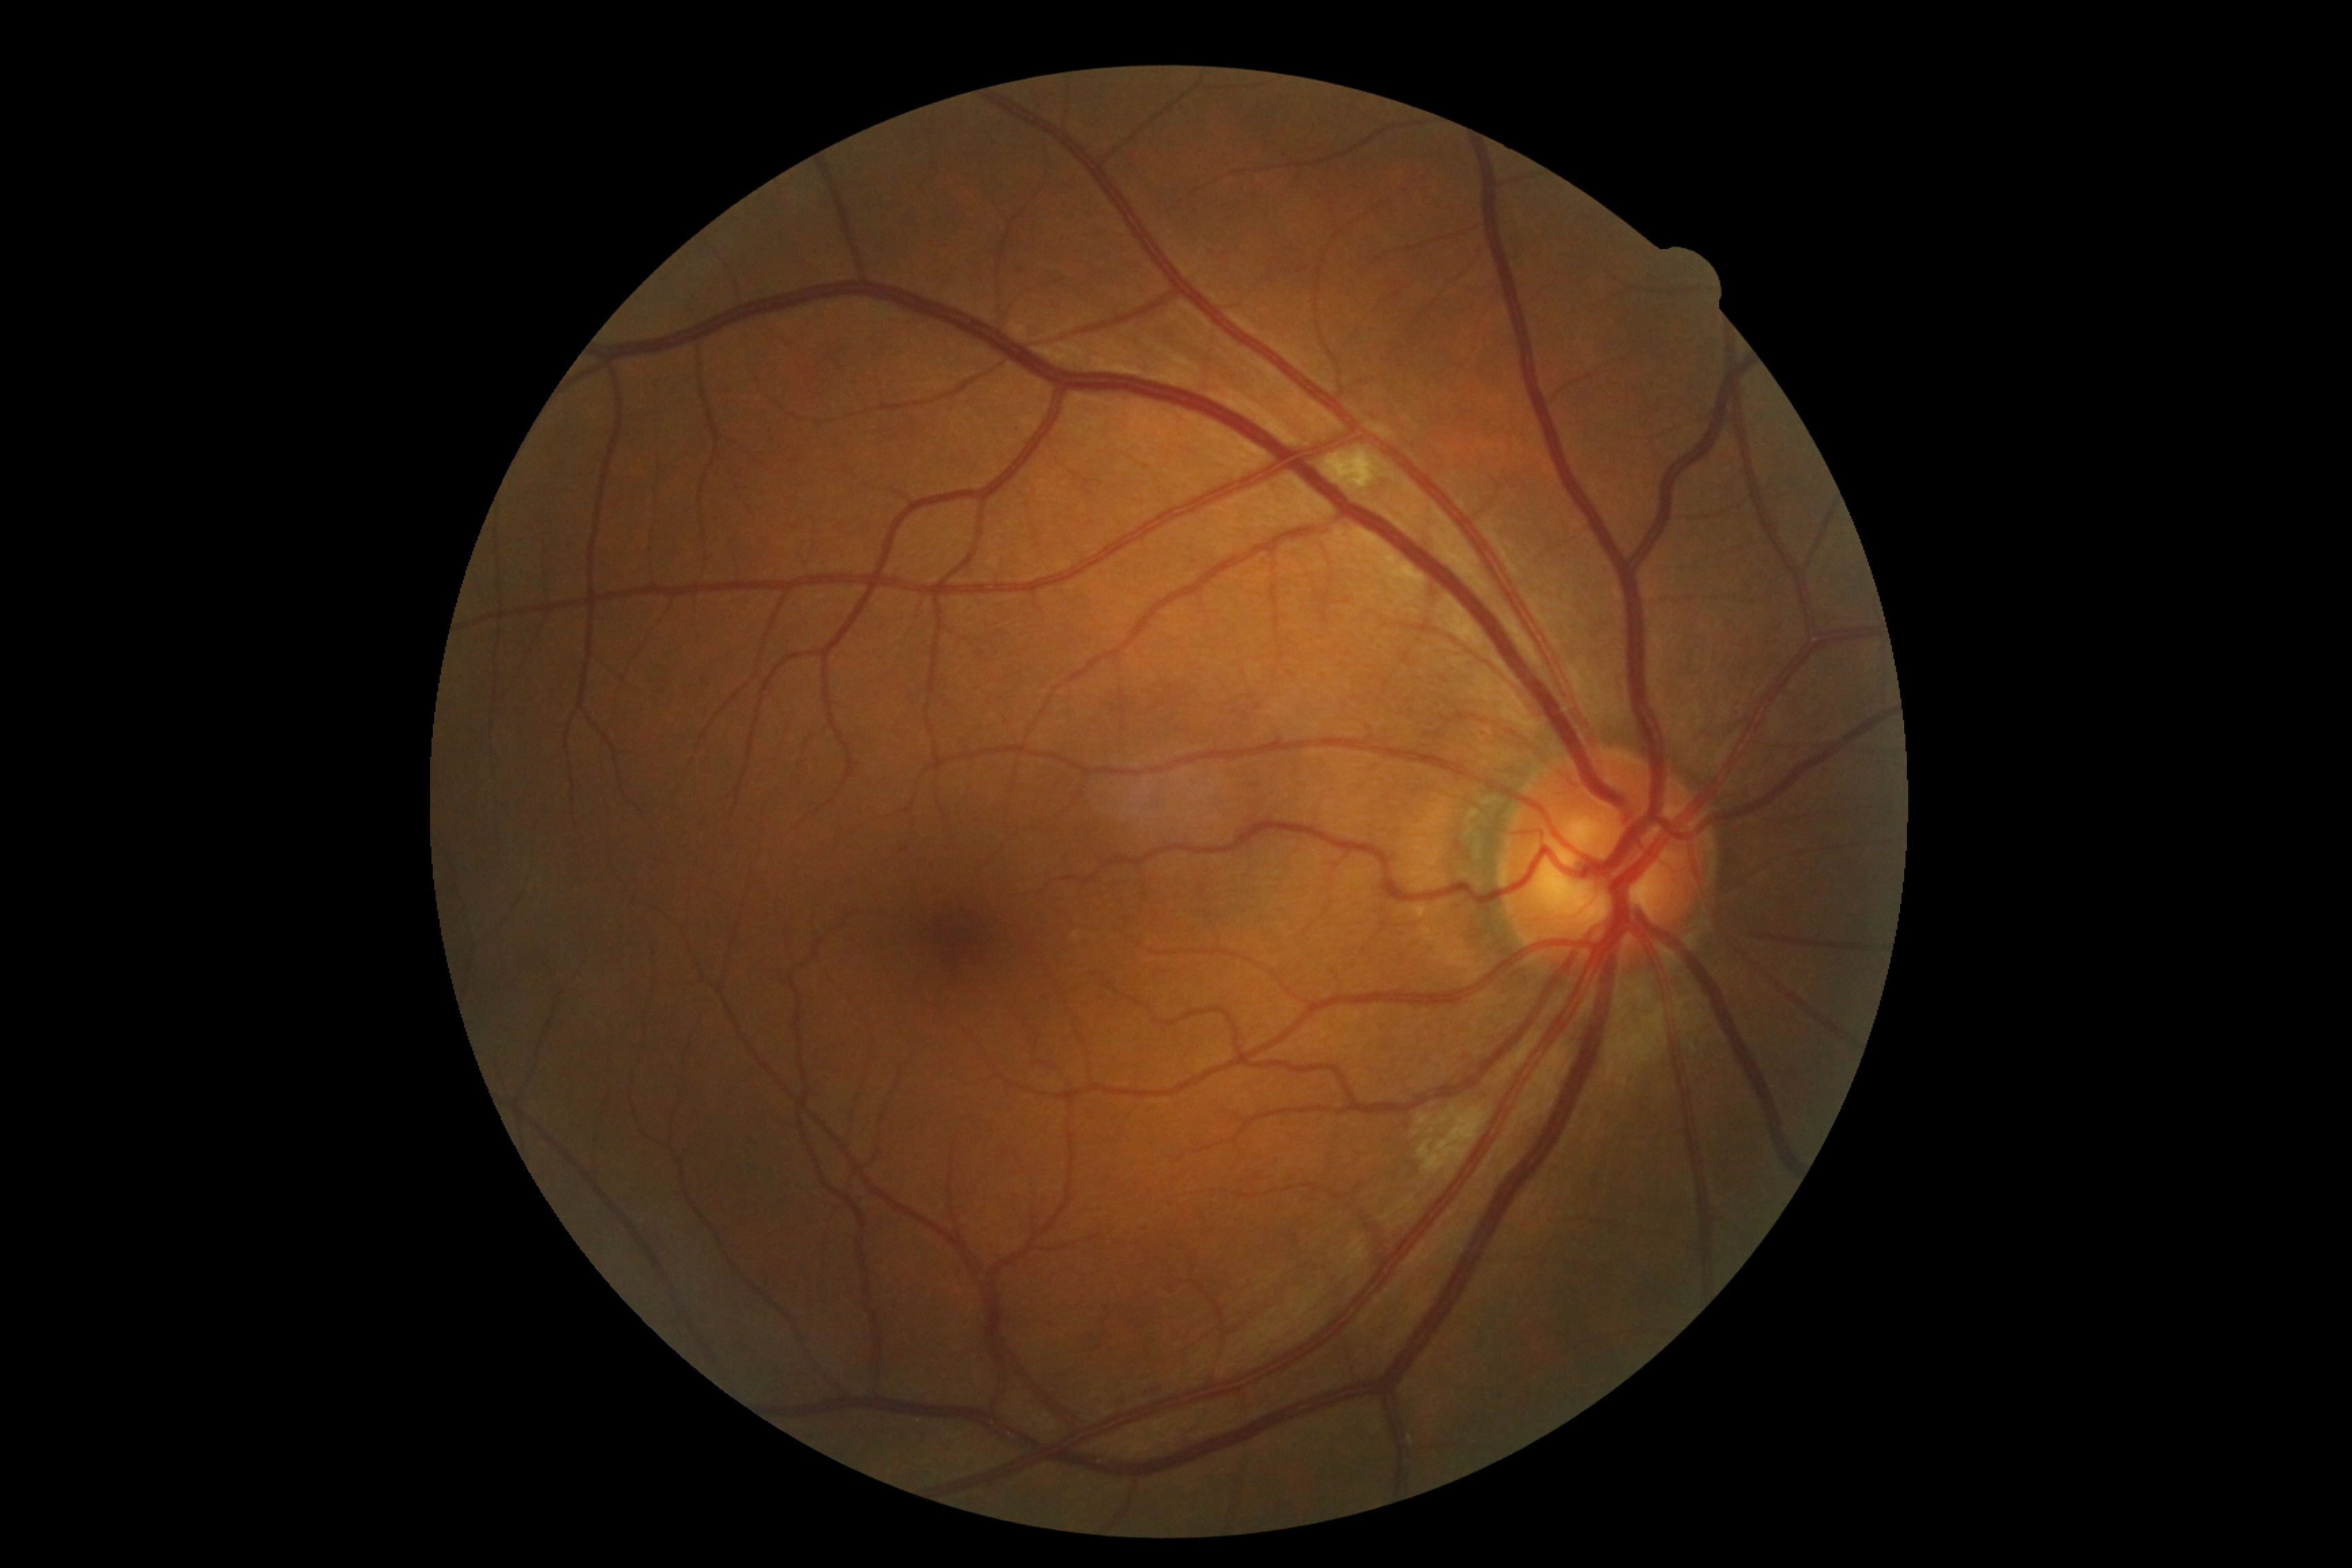 diabetic retinopathy: moderate NPDR (grade 2), DR class: non-proliferative diabetic retinopathy.